CFP; 2352x1568; 45° FOV.
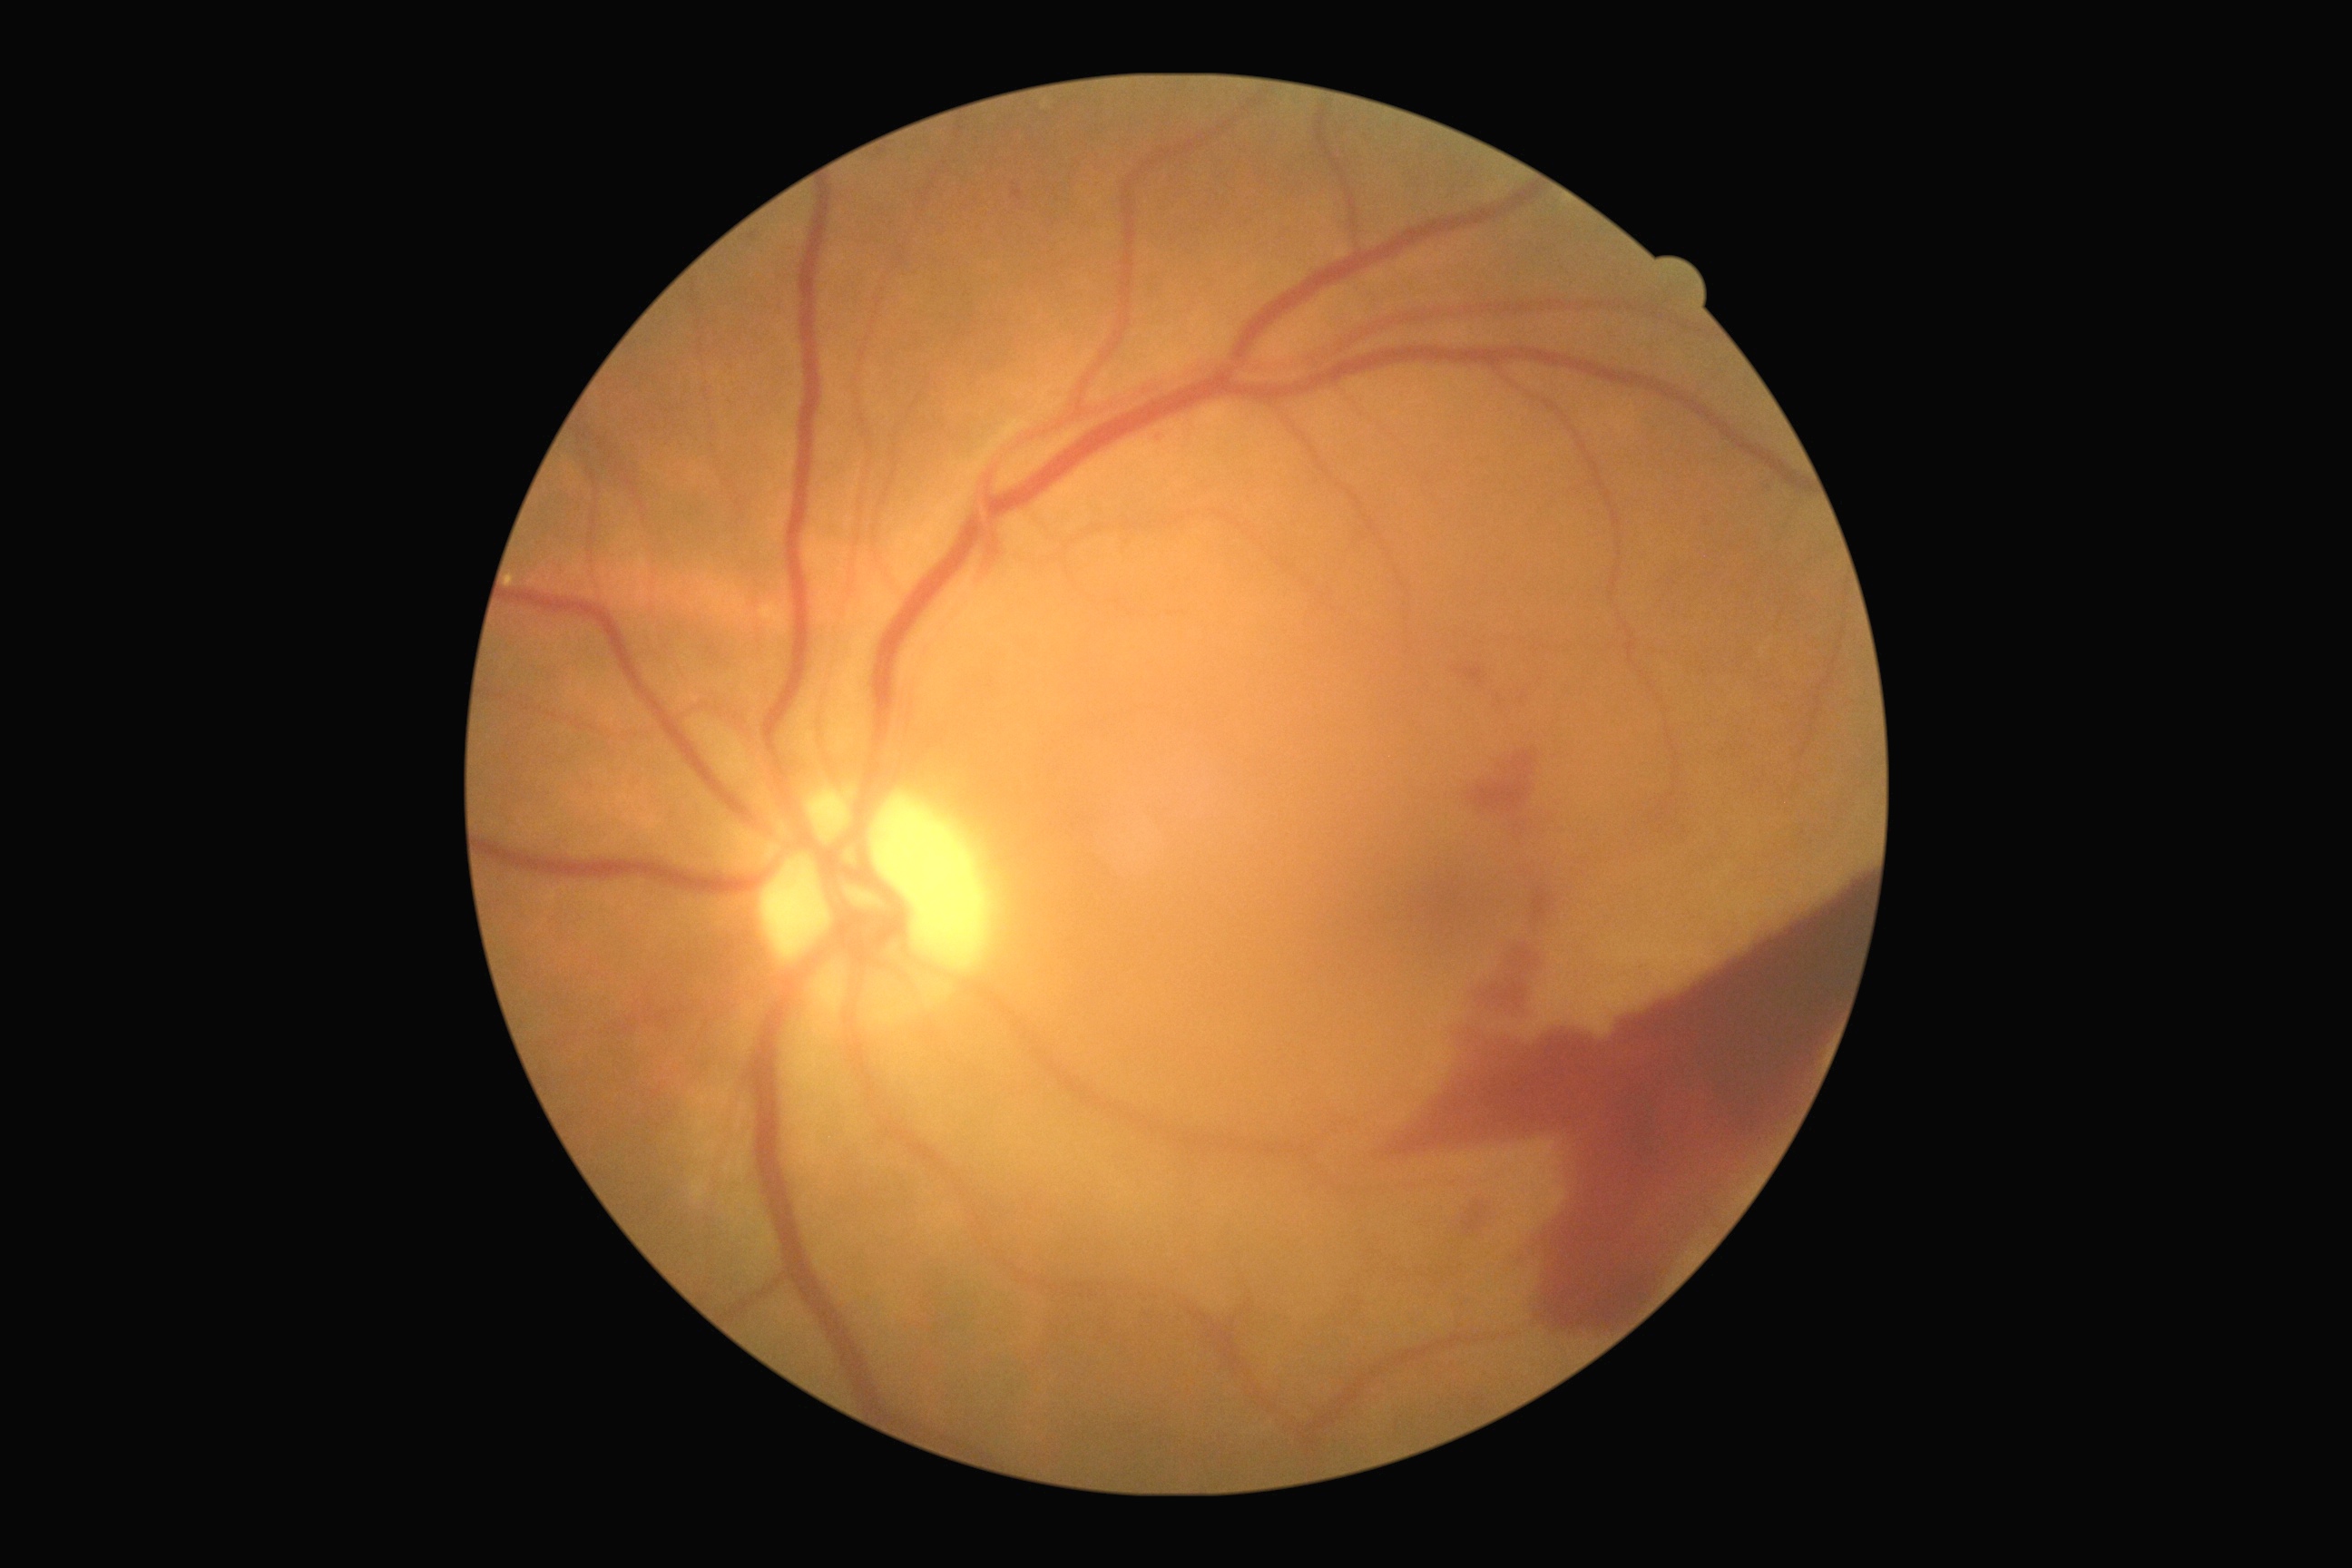 Diabetic retinopathy (DR): grade 4.